Wide-field fundus image from infant ROP screening; acquired on the Phoenix ICON:
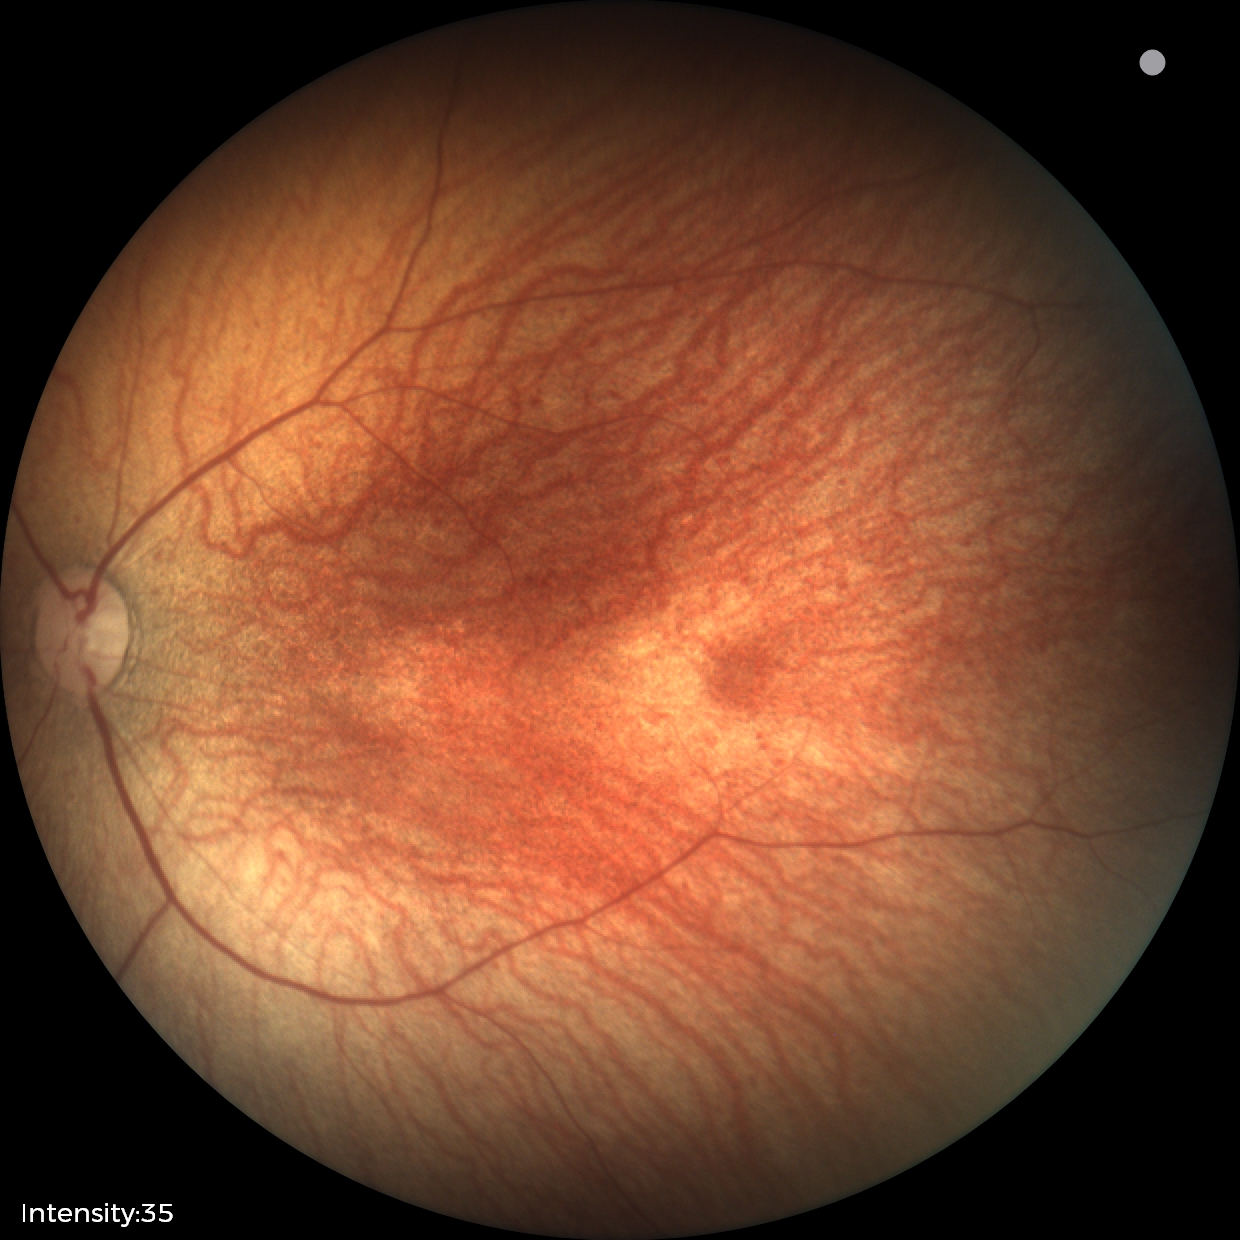

Q: What is the diagnosis from this examination?
A: normal retinal appearance